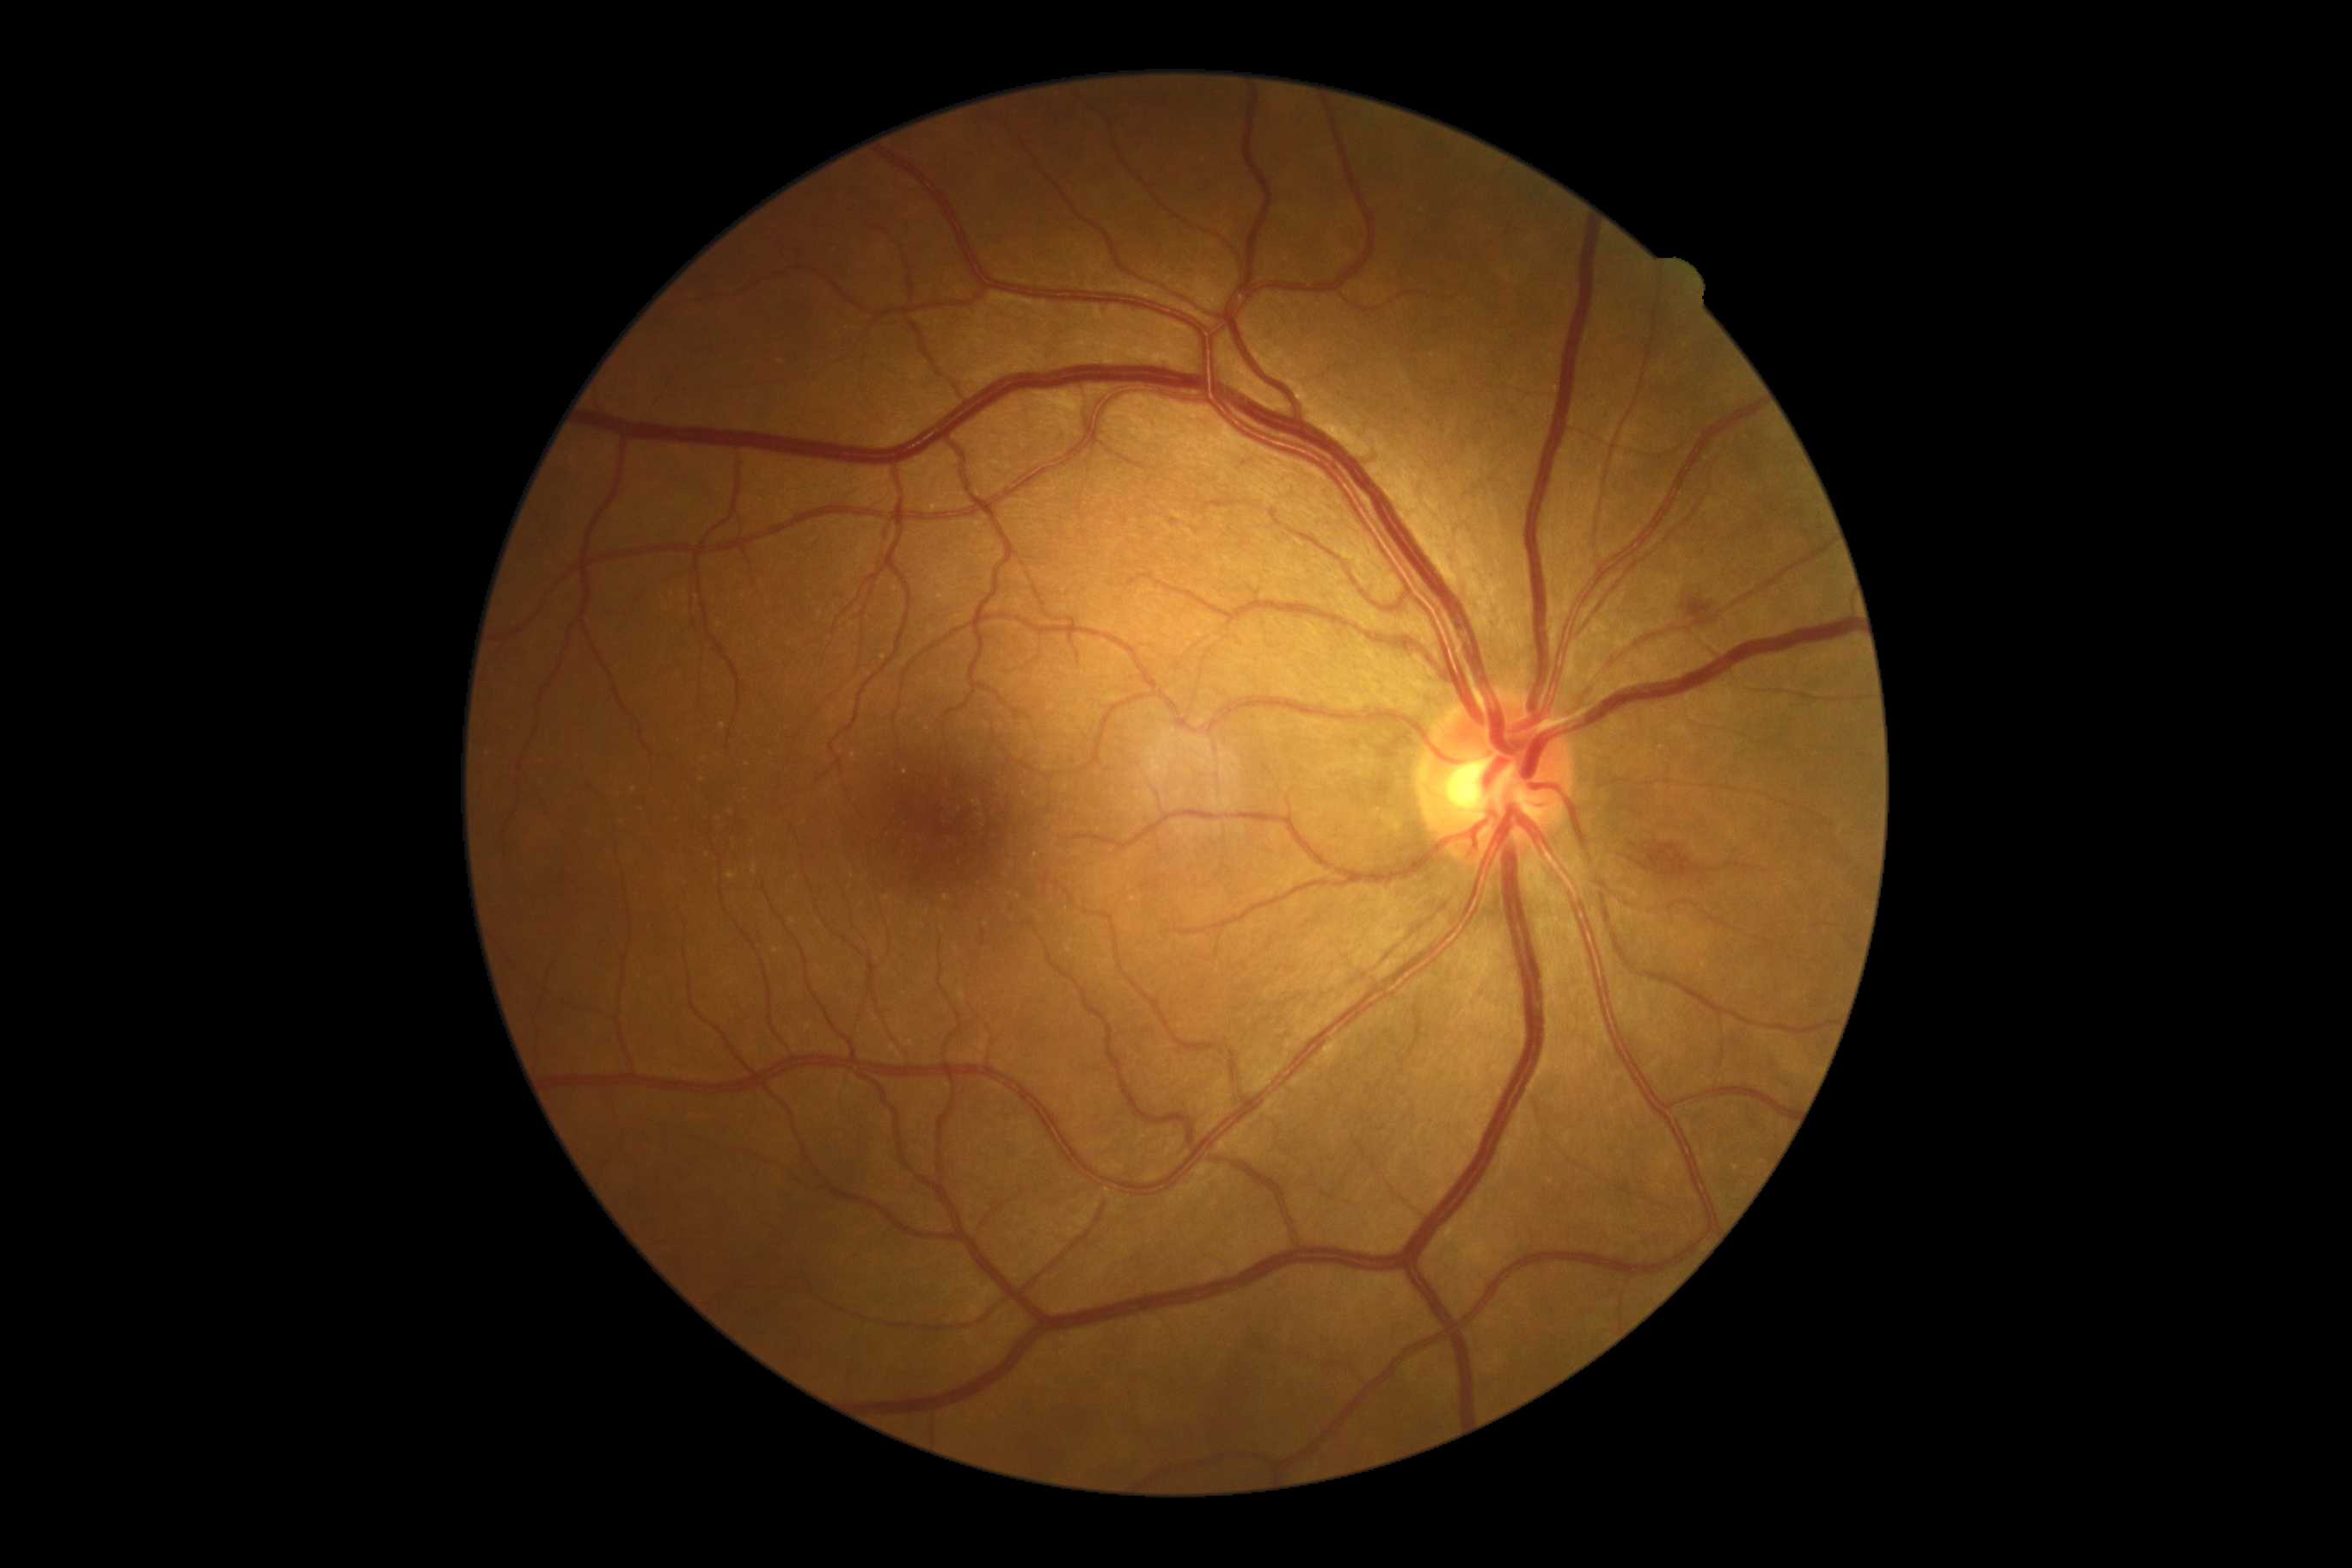 Disease class: non-proliferative diabetic retinopathy.
Diabetic retinopathy (DR): moderate NPDR (grade 2).